240 by 240 pixels:
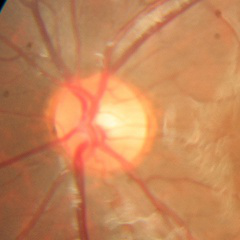

Q: What stage of glaucoma is present?
A: No — no glaucomatous optic neuropathy.